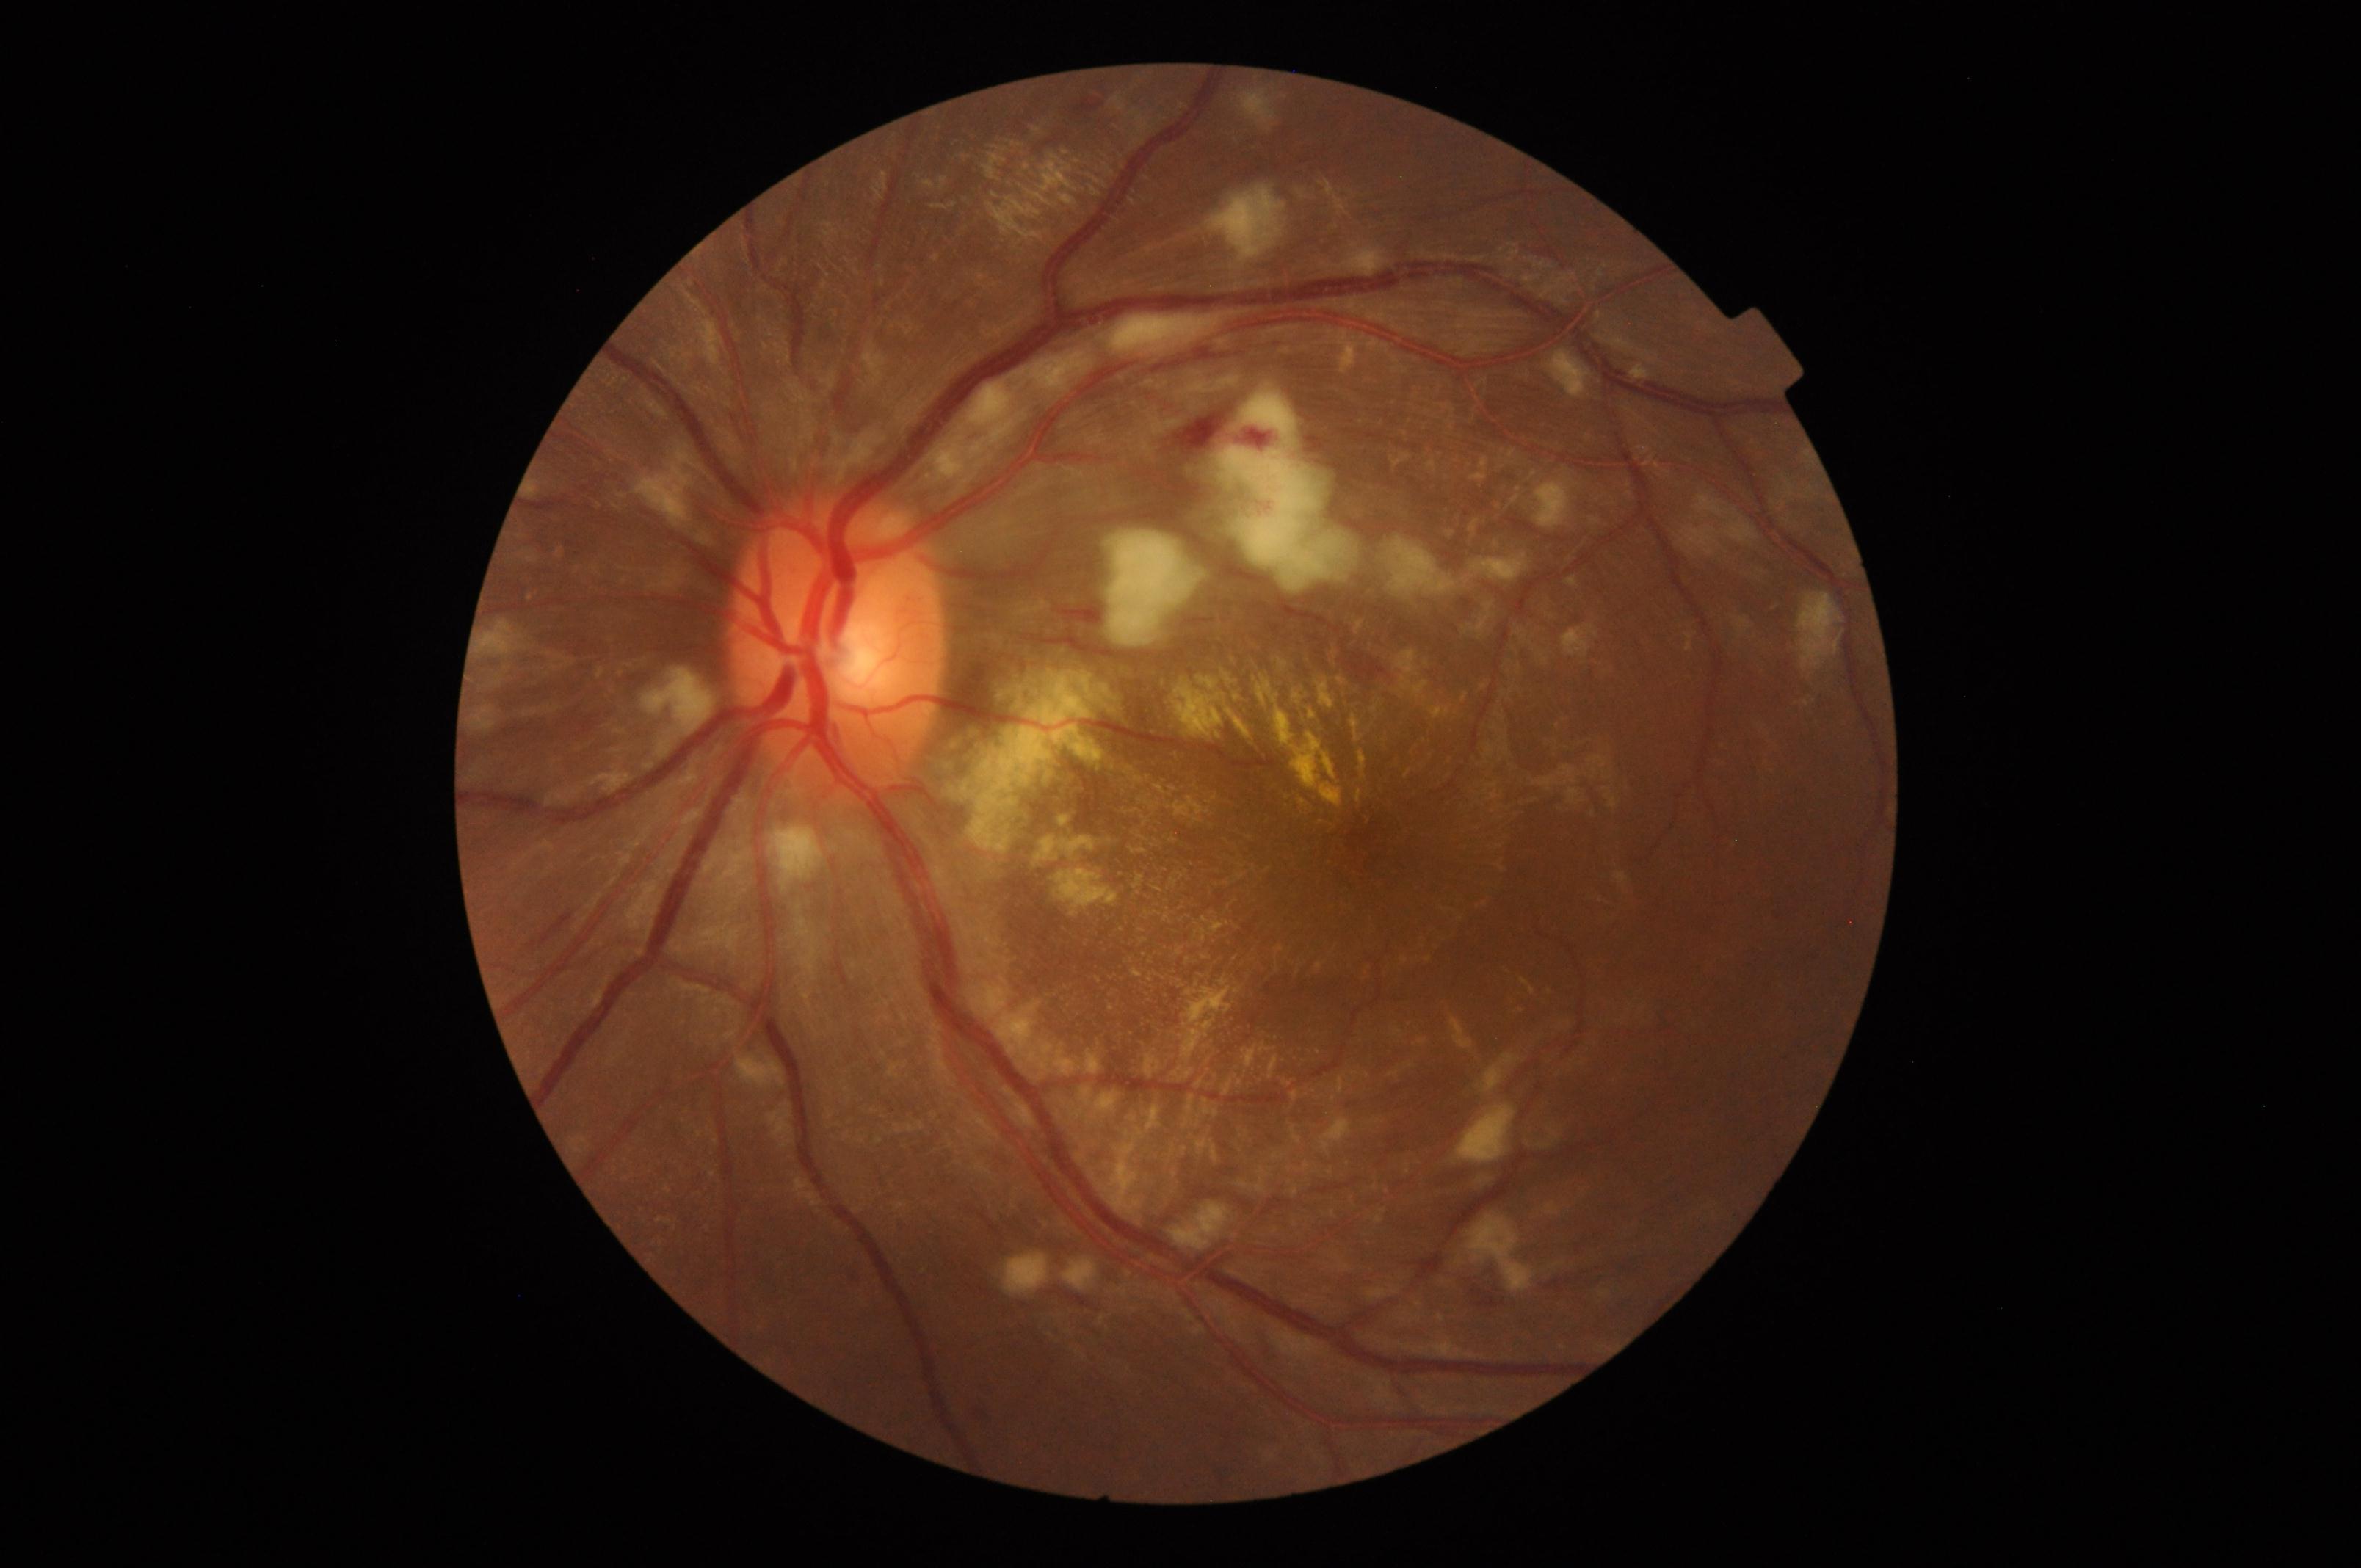

Diagnosis: severe hypertensive retinopathy.